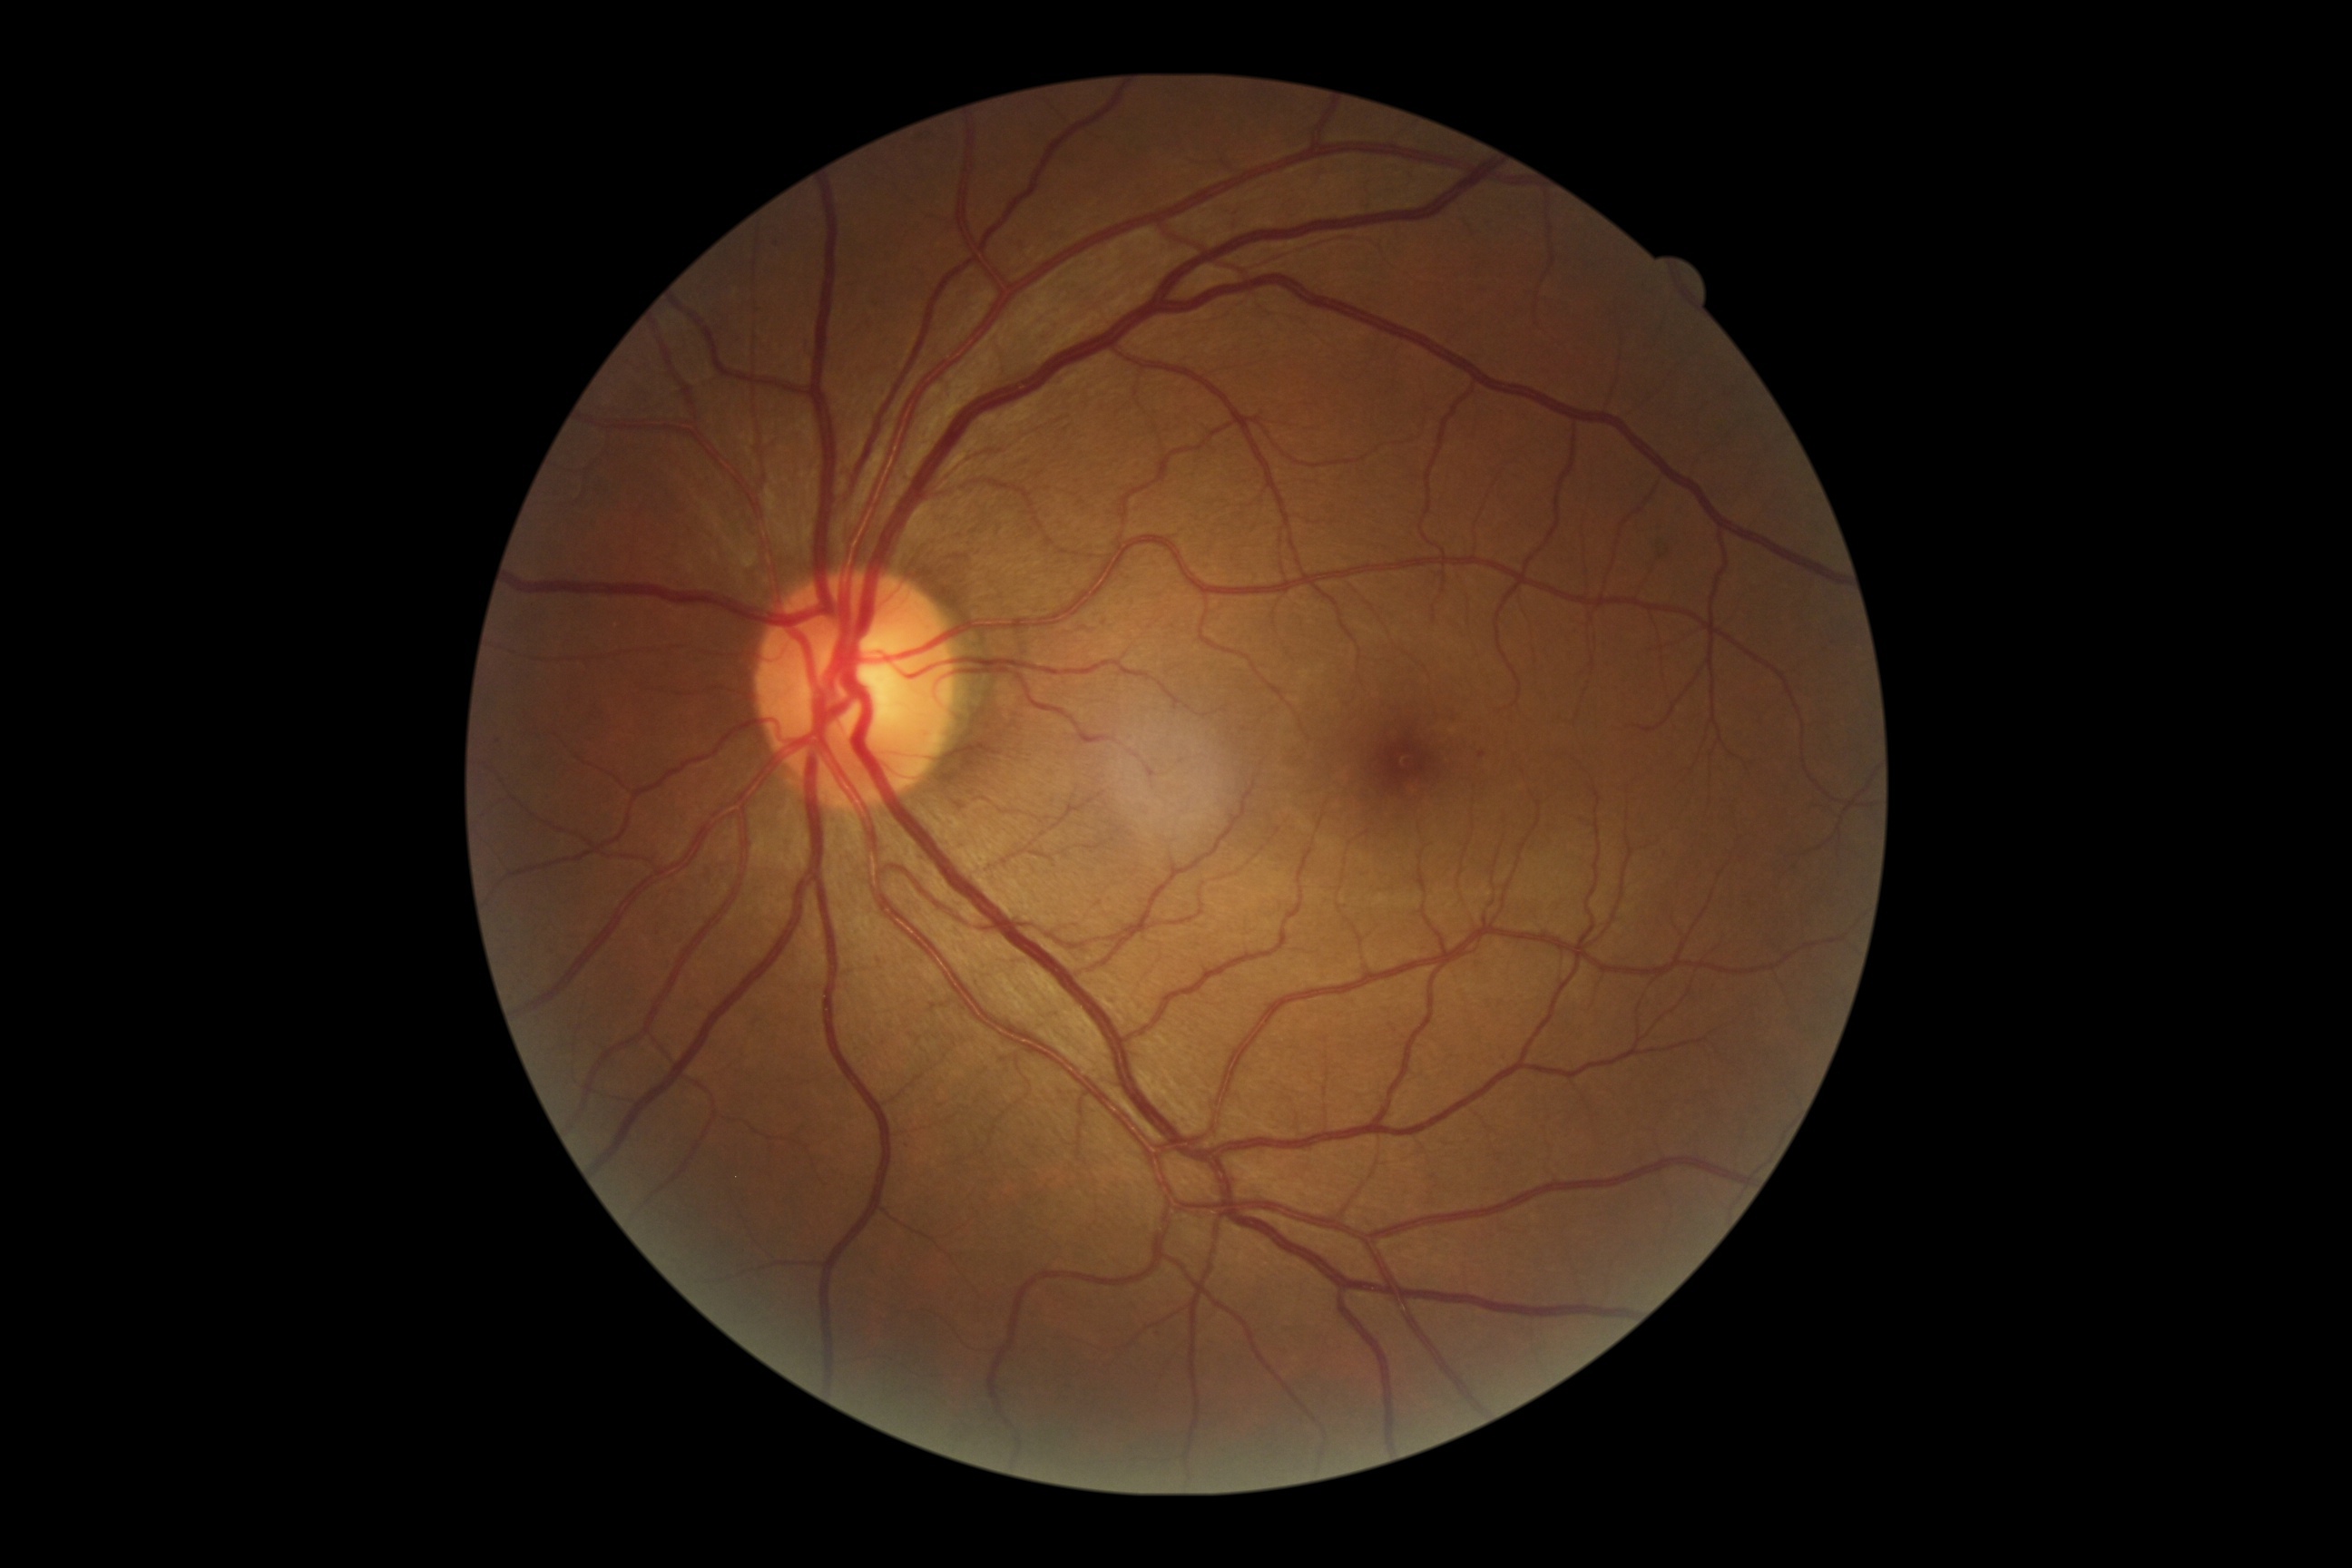

Diabetic retinopathy (DR) is grade 1 (mild NPDR).